CFP; 45° field of view — 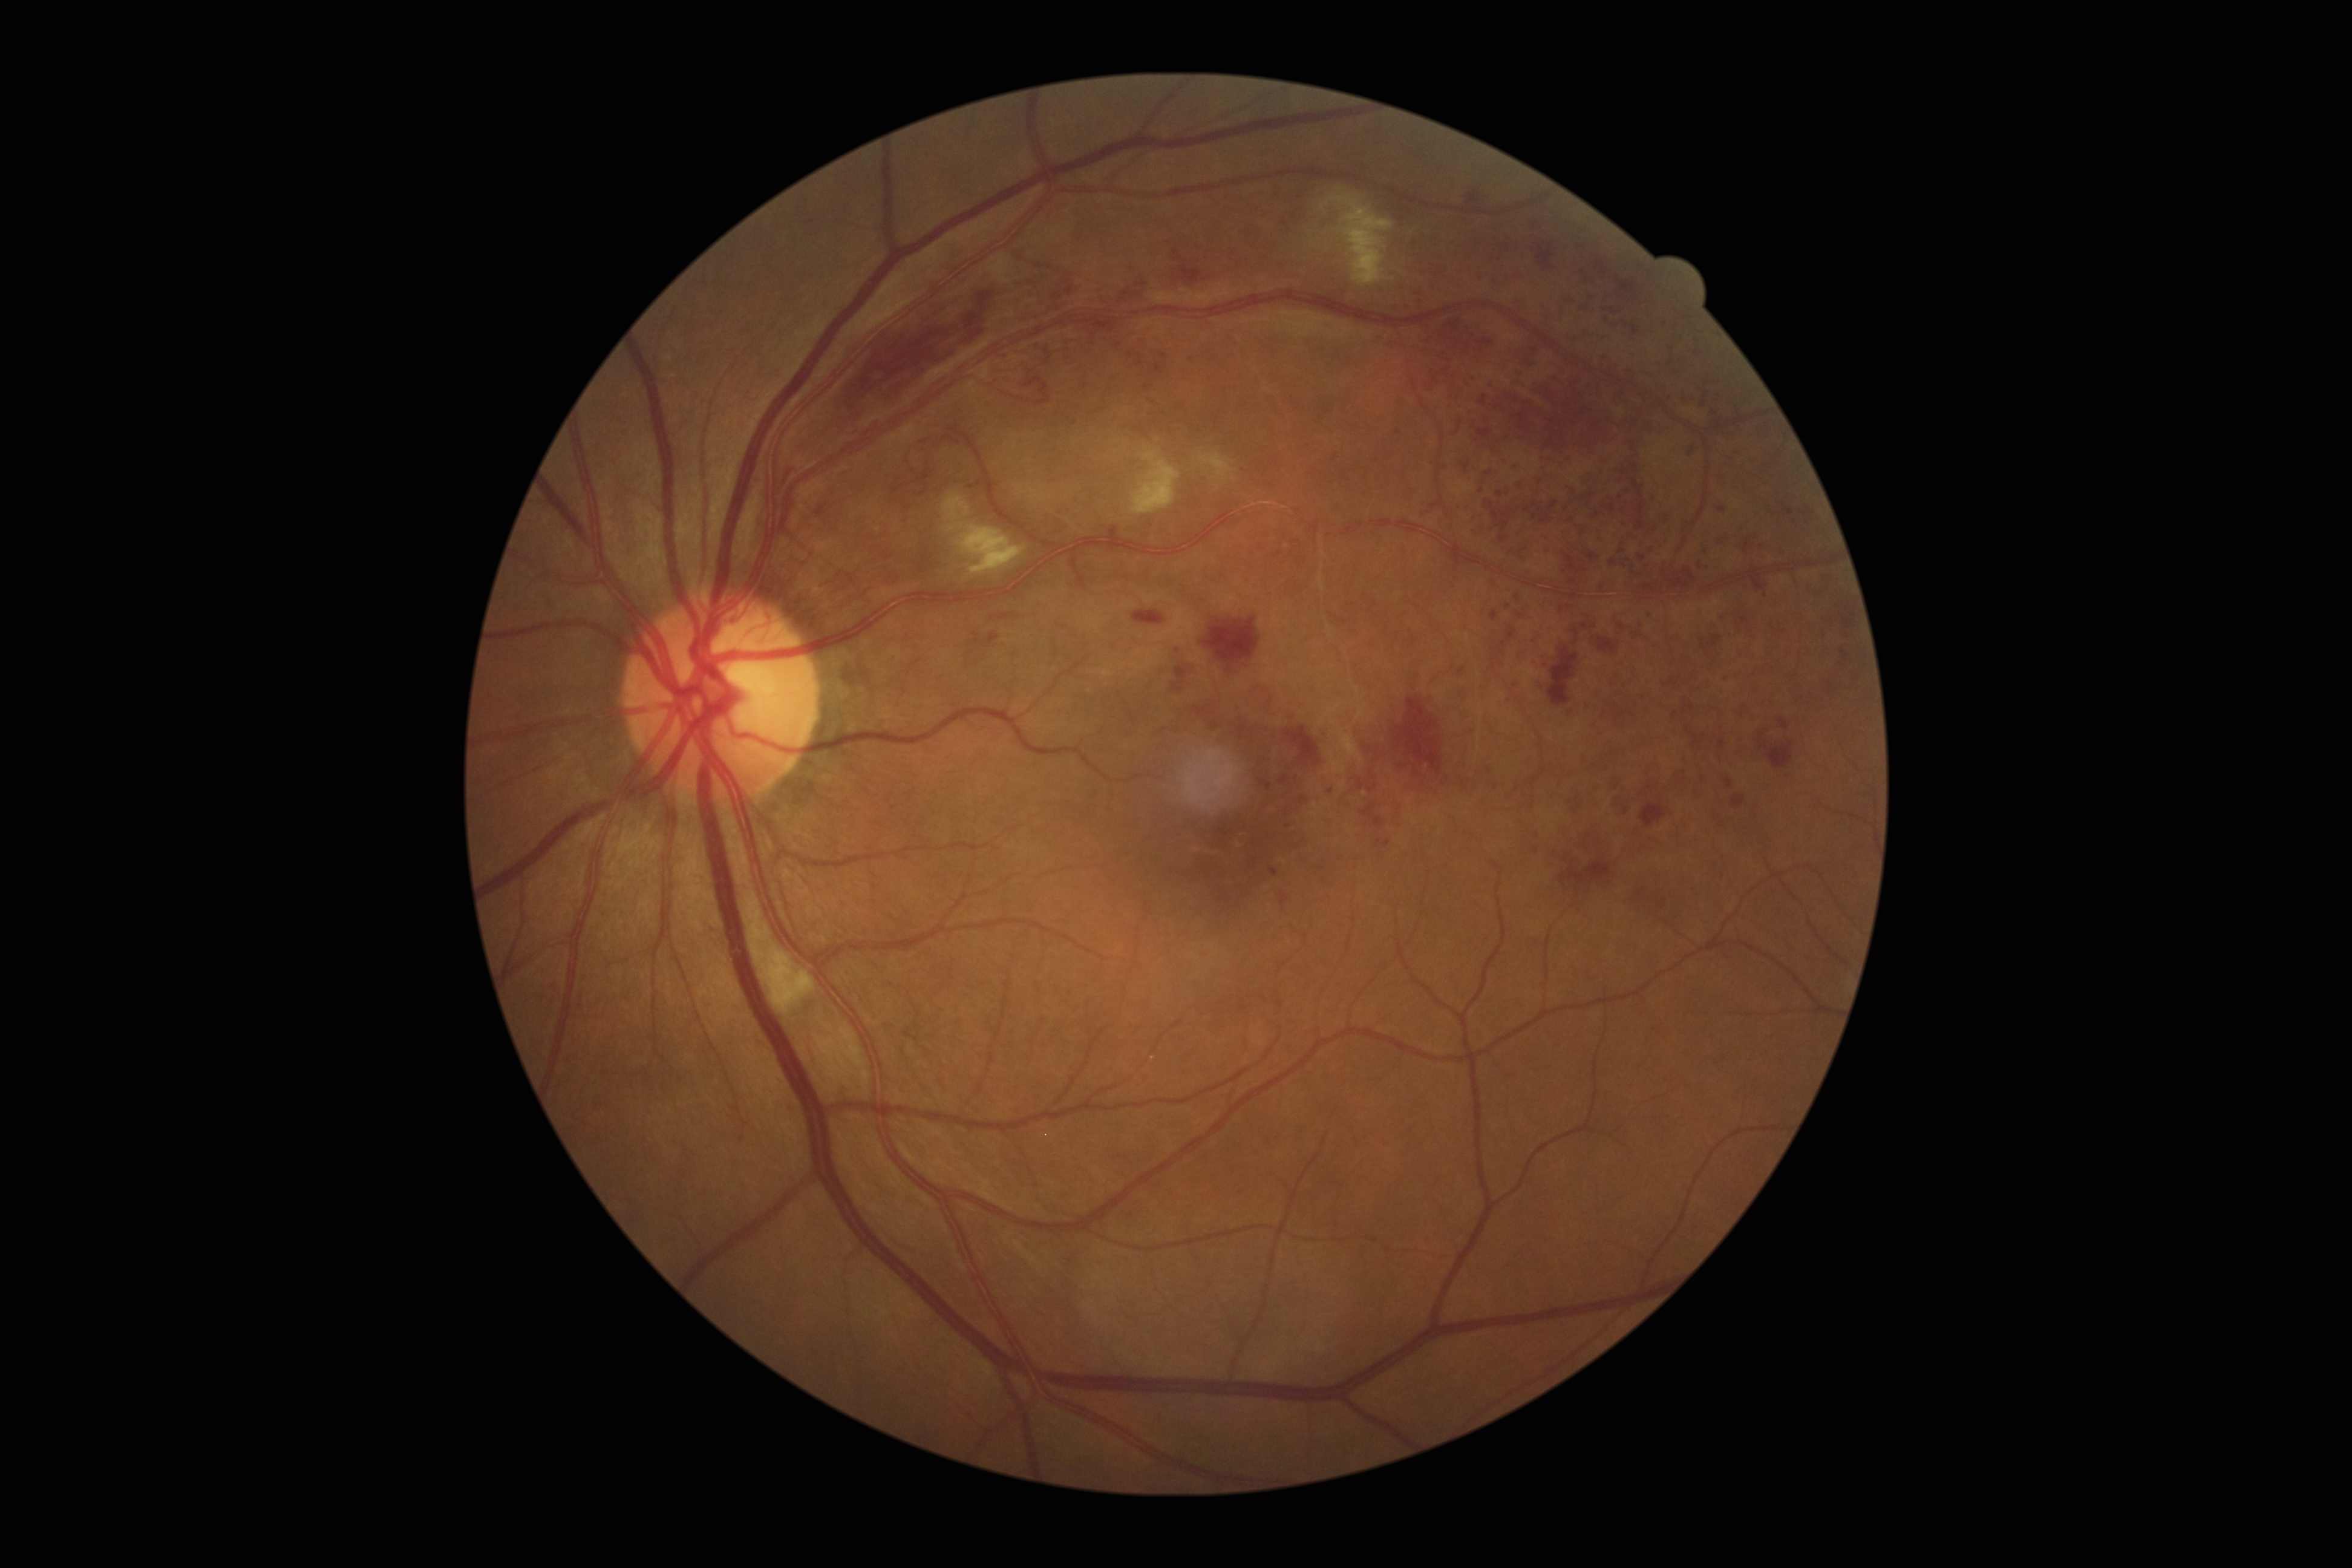

Diabetic retinopathy (DR): proliferative diabetic retinopathy (grade 4) — neovascularization and/or vitreous/pre-retinal hemorrhage.